Captured with the Natus RetCam Envision (130° field of view) · wide-field fundus photograph from neonatal ROP screening
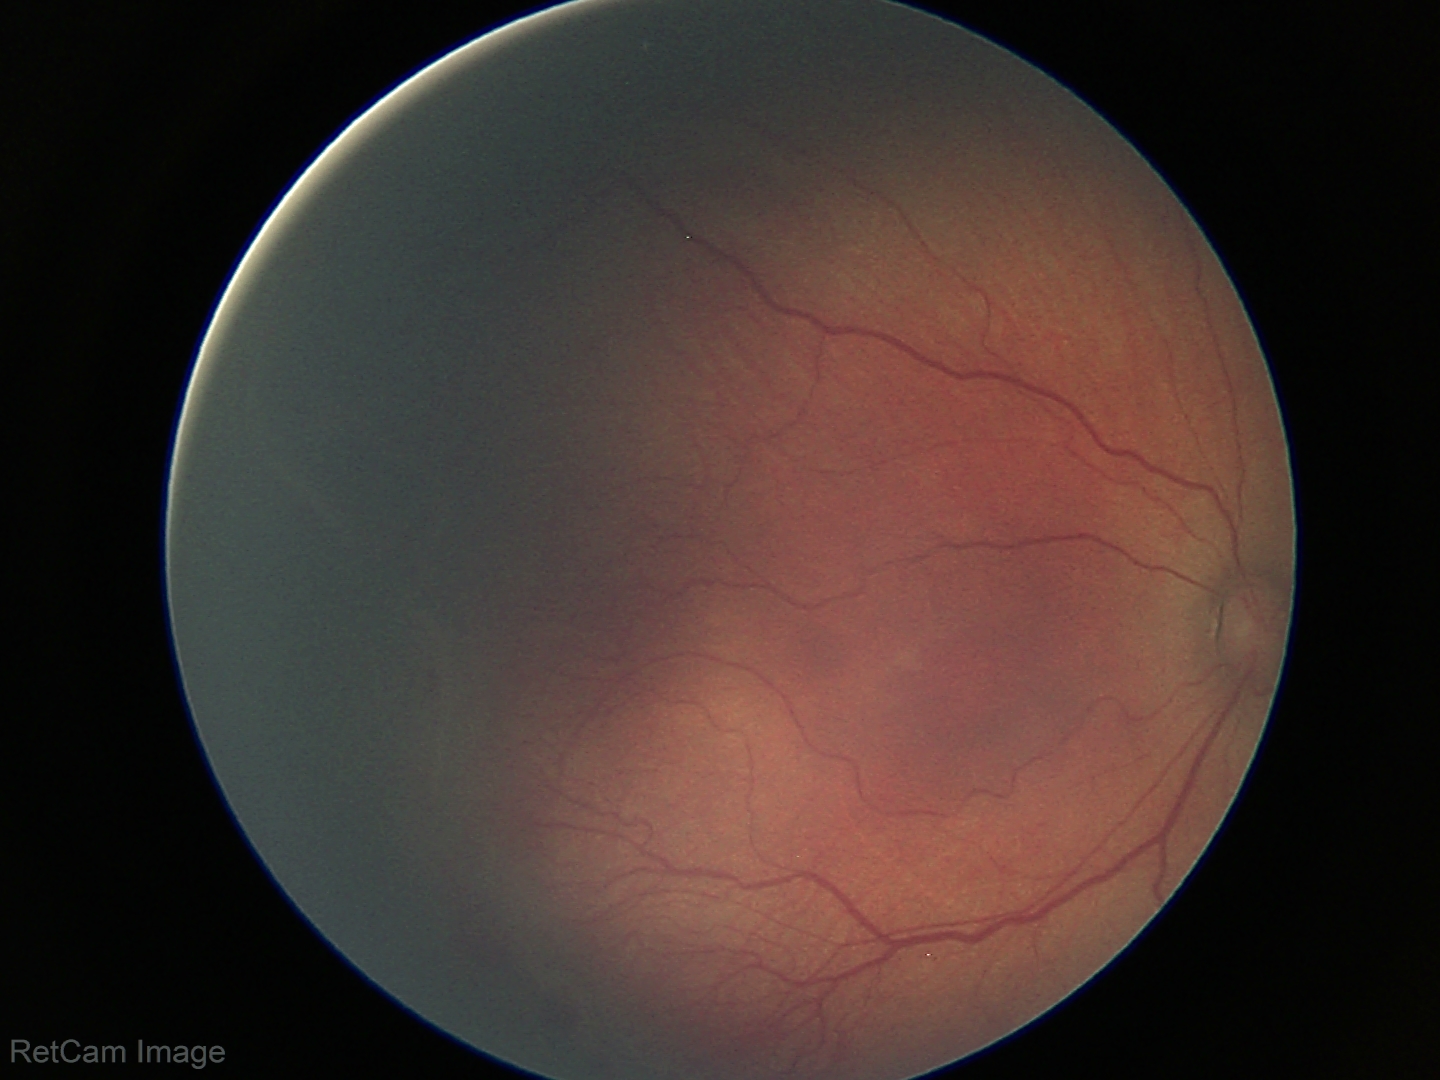

Plus disease absent. Screening examination consistent with ROP stage 2.